Non-mydriatic; sex: M; CFP; patient age: 51 years; axial length (AL) 27.75 mm; centered on the optic disc; Topcon TRC-NW400; intraocular pressure (IOP) (non-contact tonometry): 20 mmHg; FOV: 30 degrees.
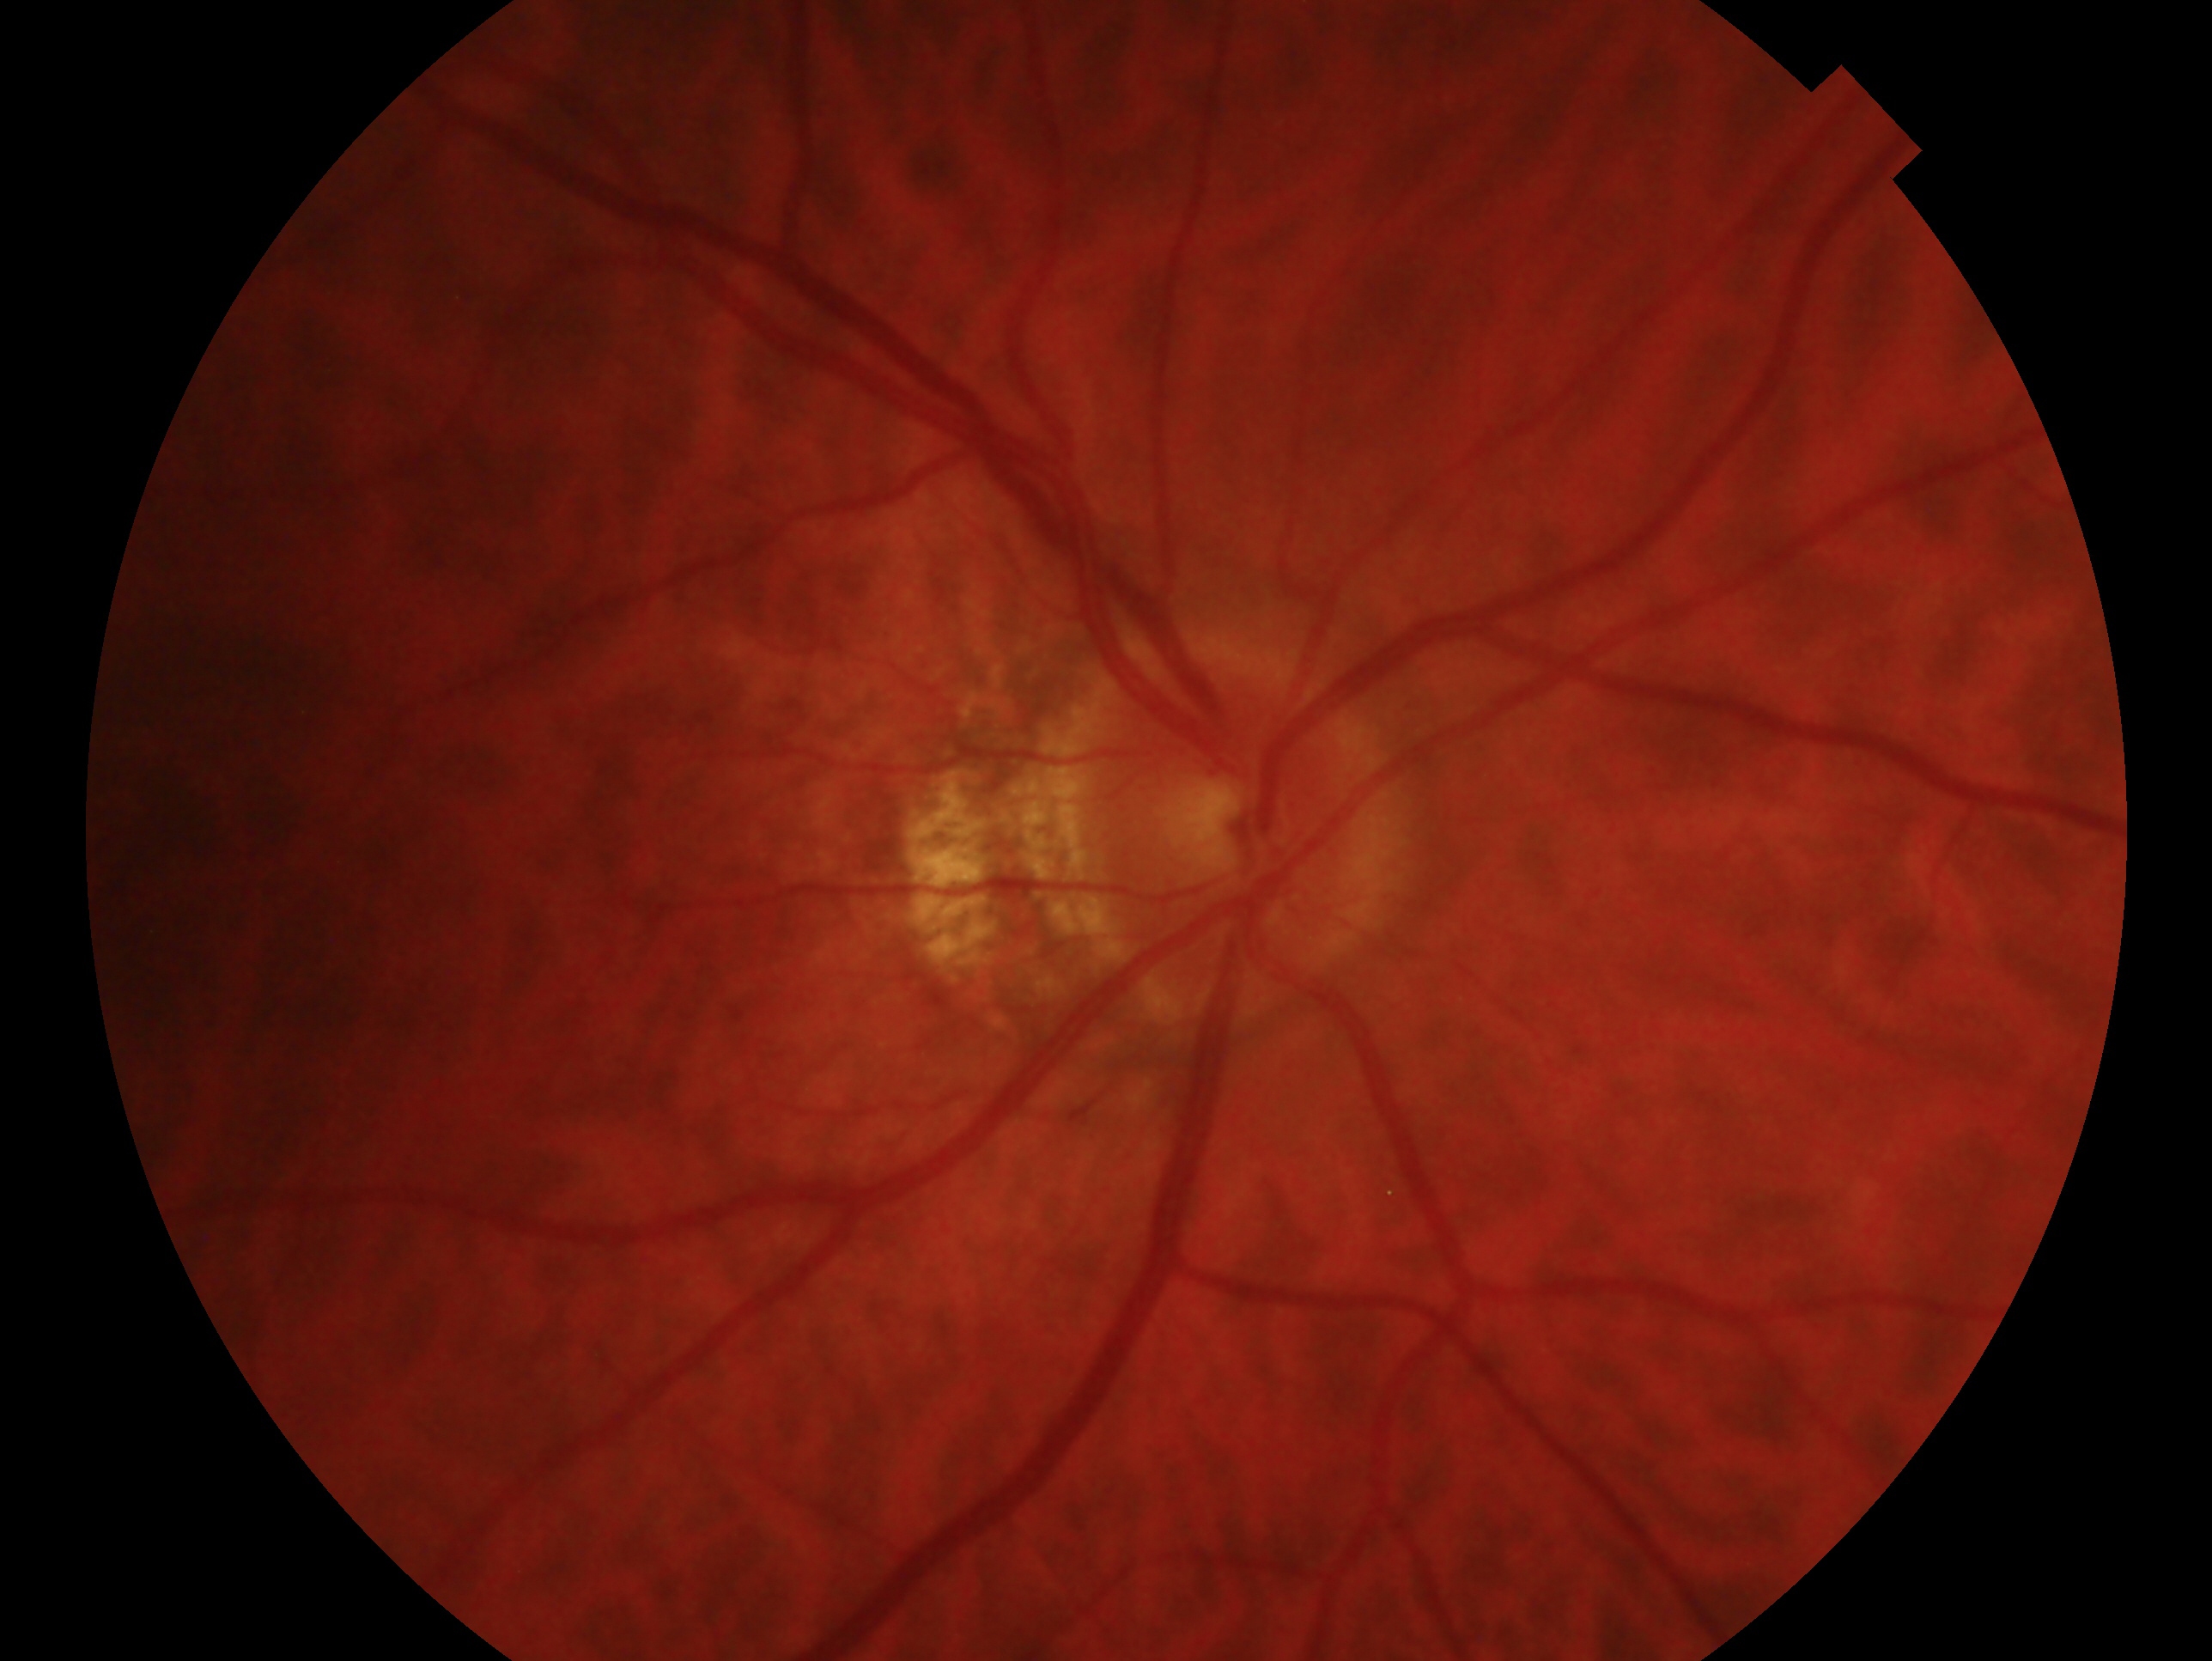 • eye — OD
• glaucoma status — cannot be excluded